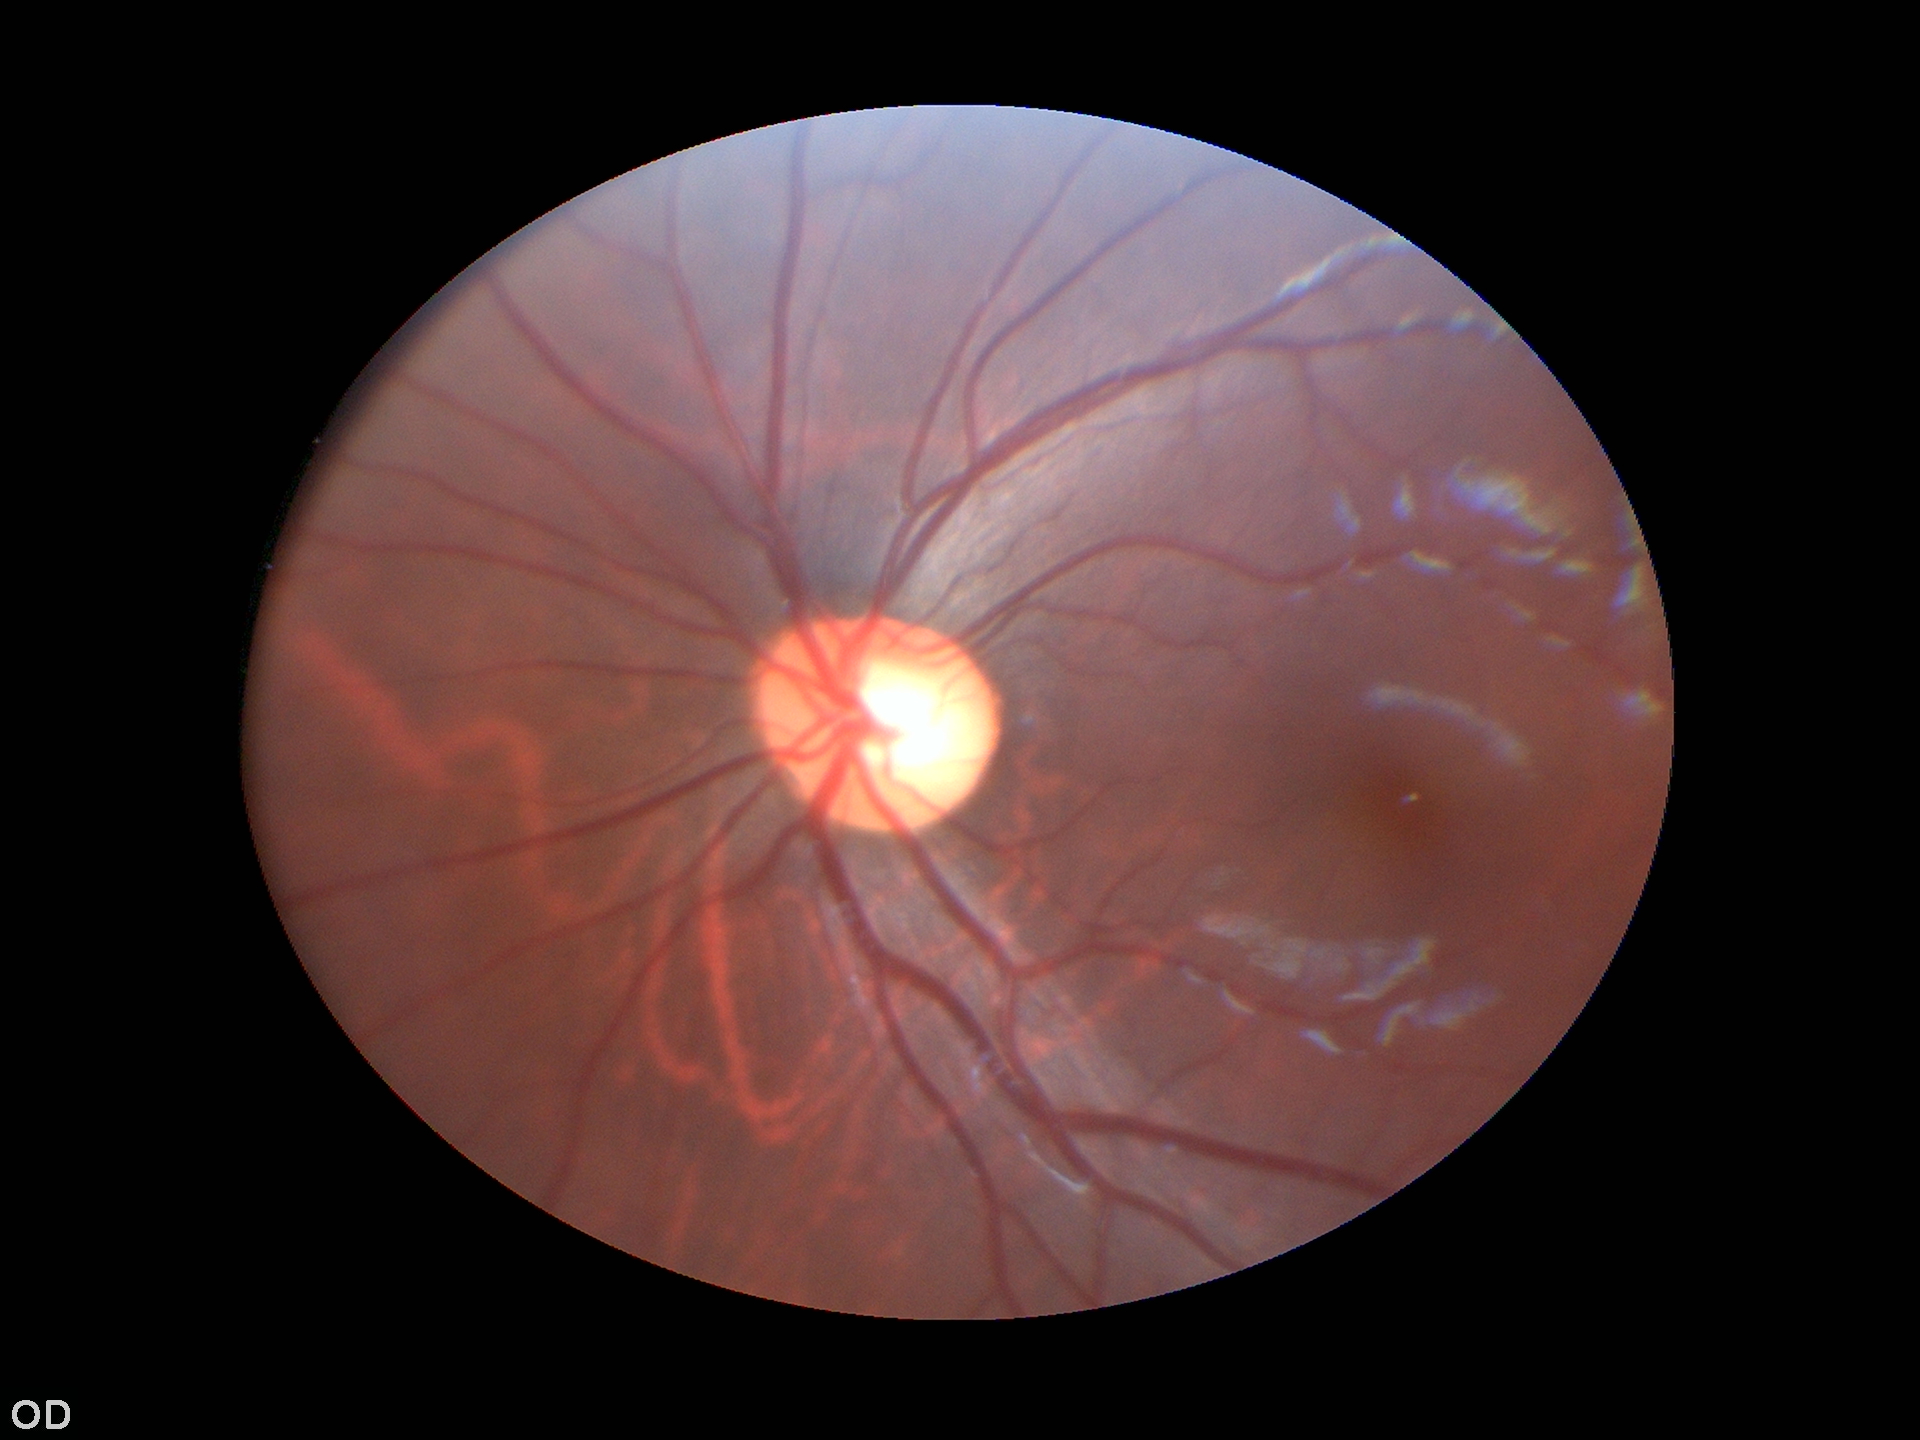
Glaucoma assessment: not suspect (2/5 graders called glaucoma suspect)
vertical CDR (VCDR): 0.59